45° field of view:
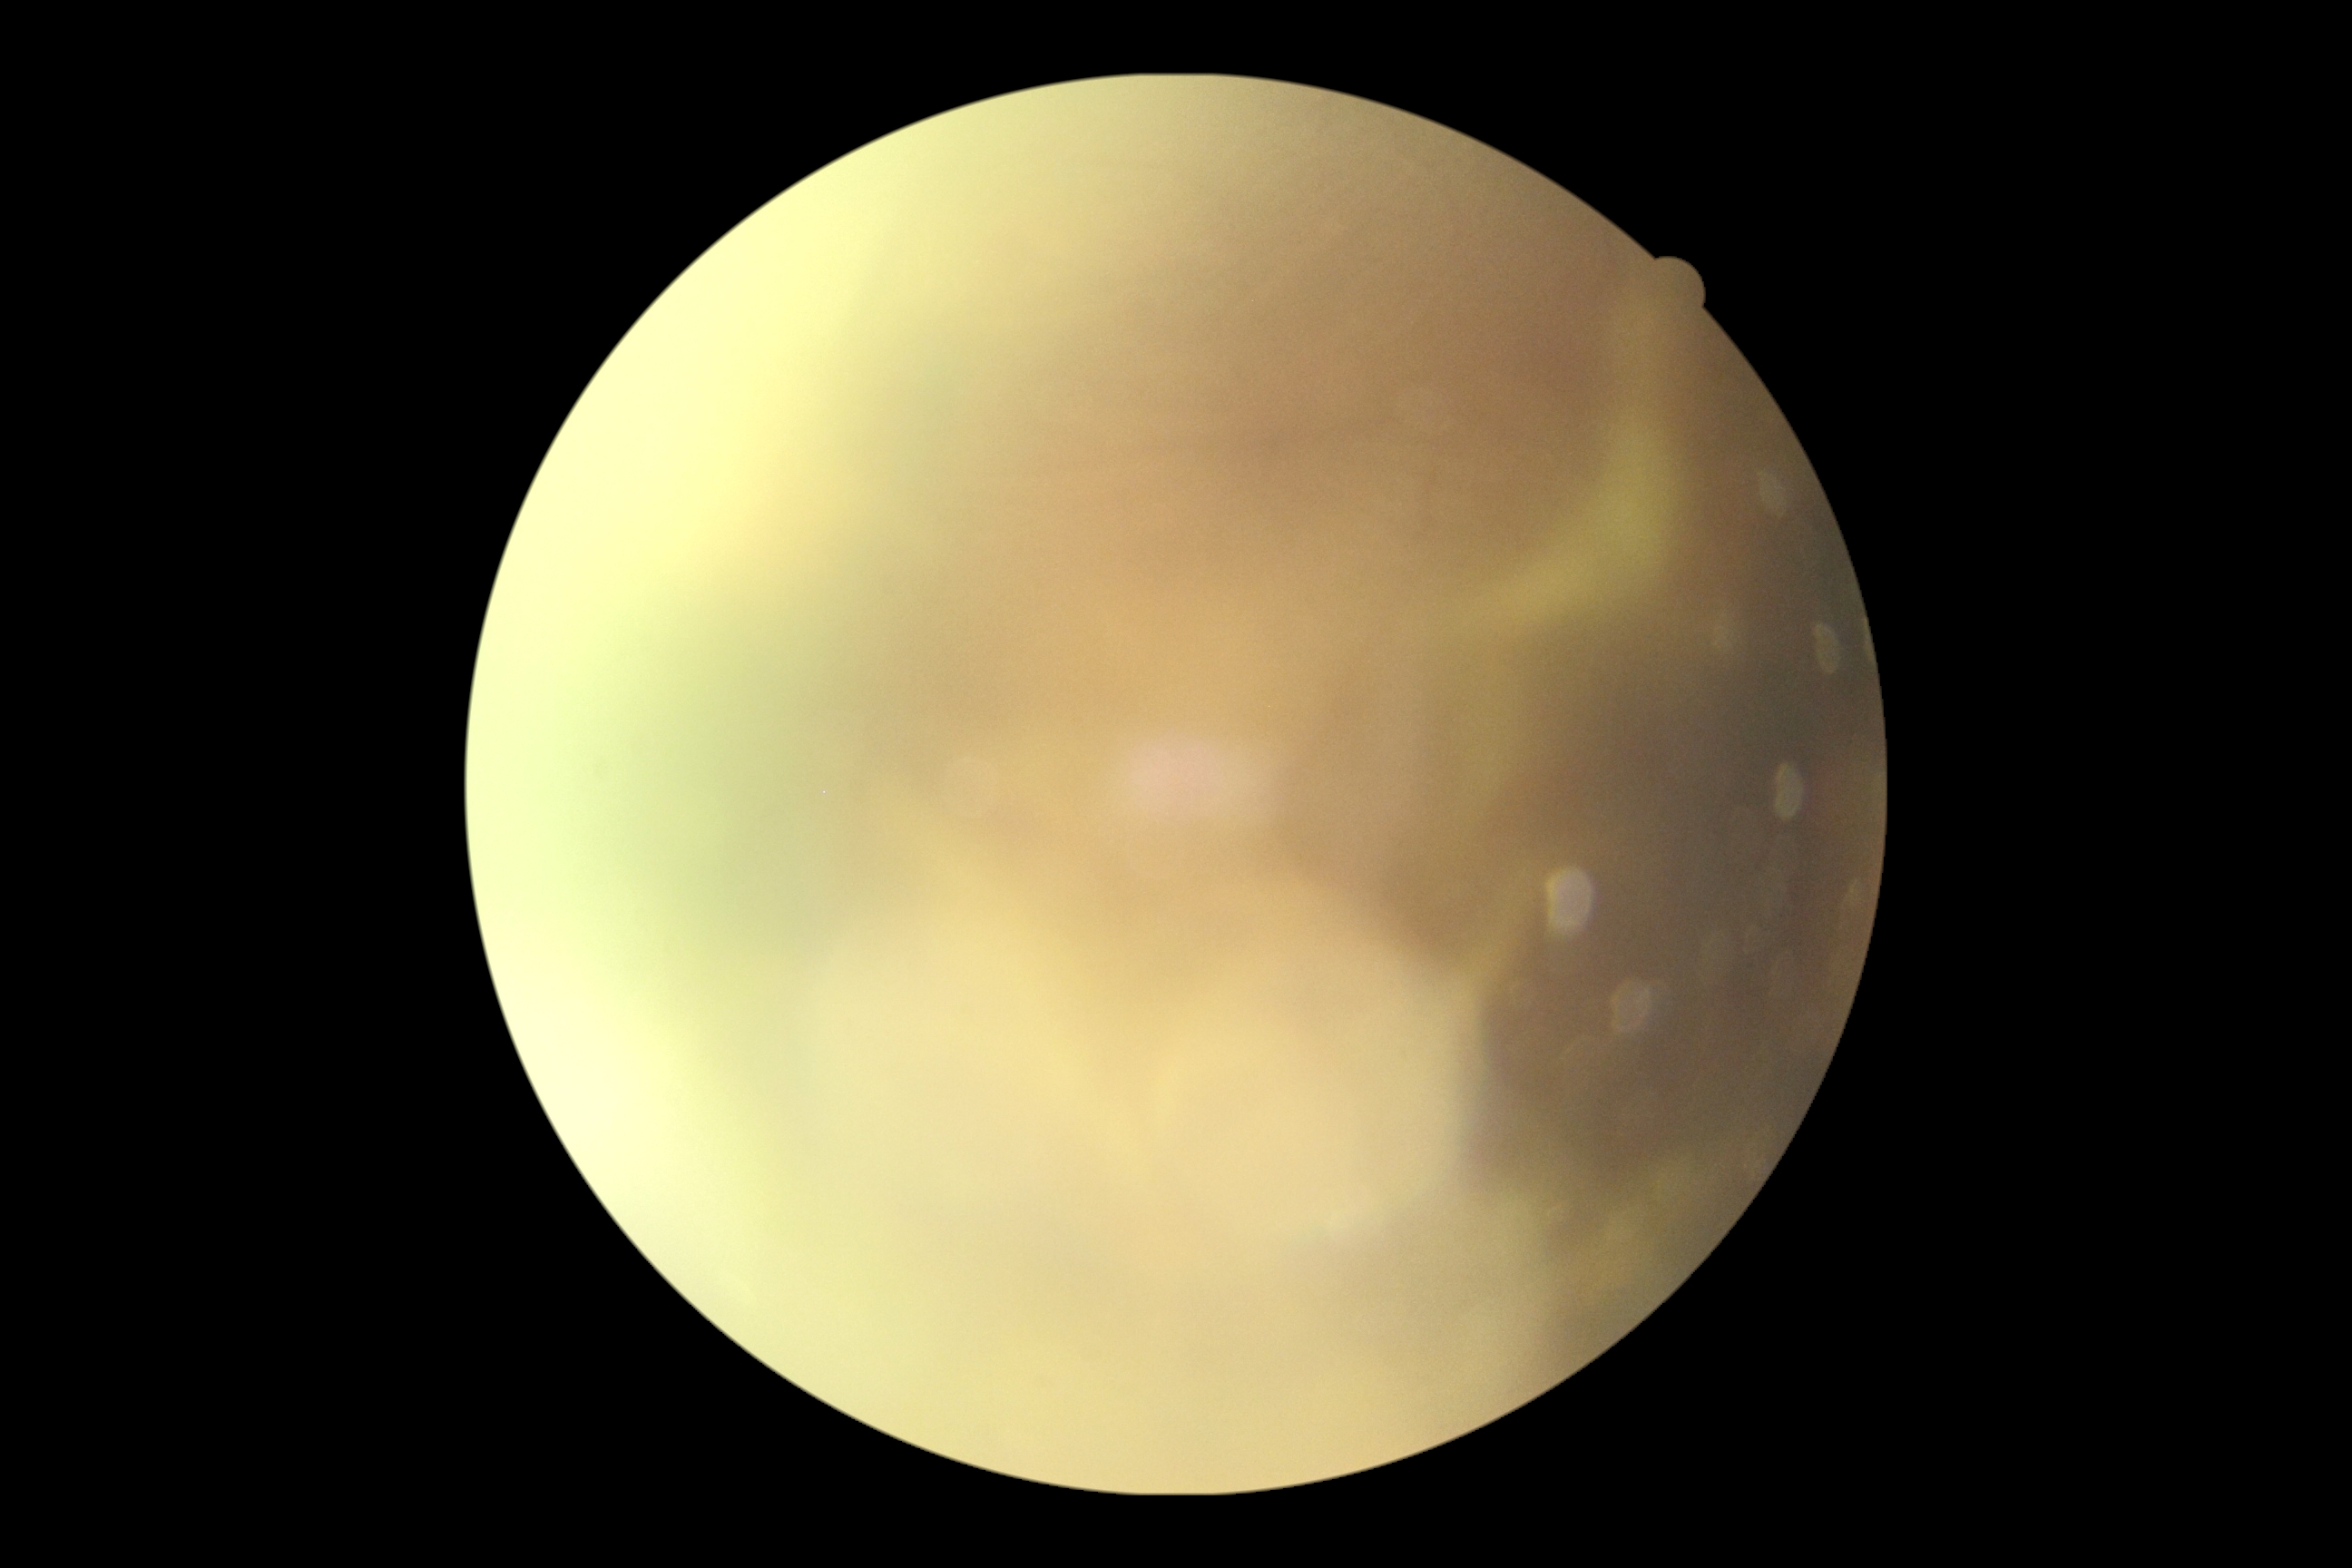
DR grade: ungradable due to poor image quality.